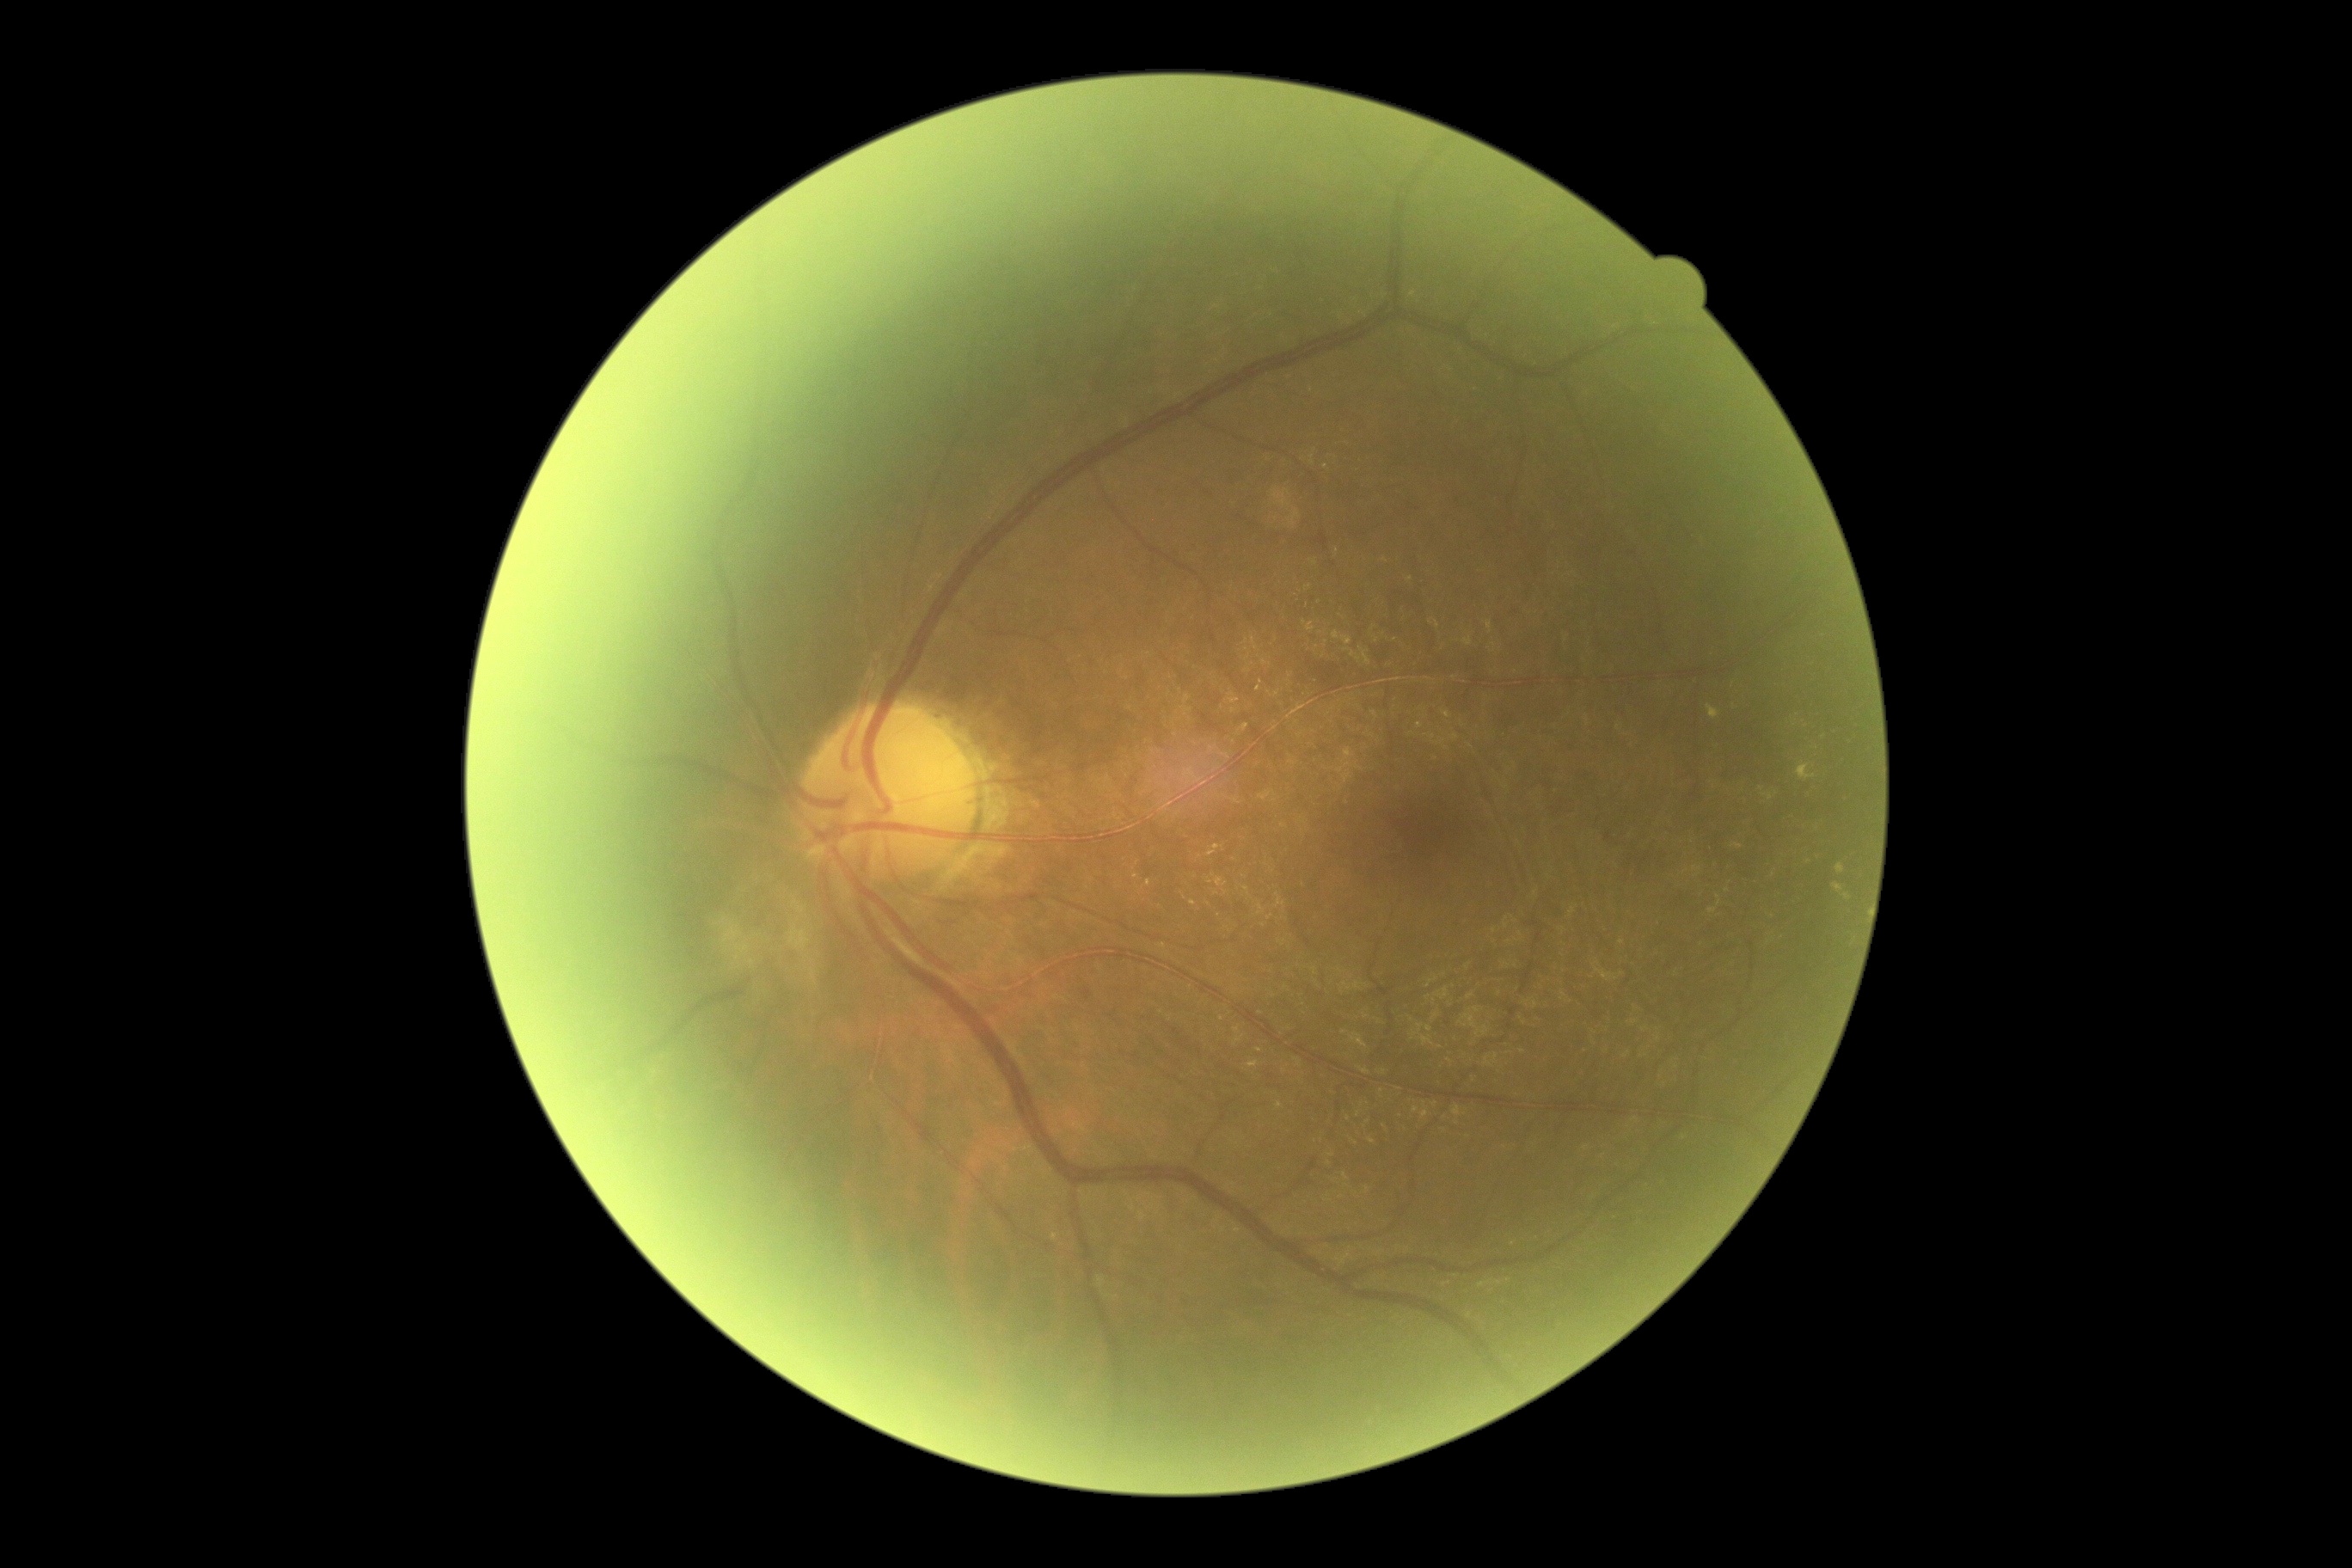
Retinopathy is grade 2 (moderate NPDR). DR class: non-proliferative diabetic retinopathy.